848 by 848 pixels:
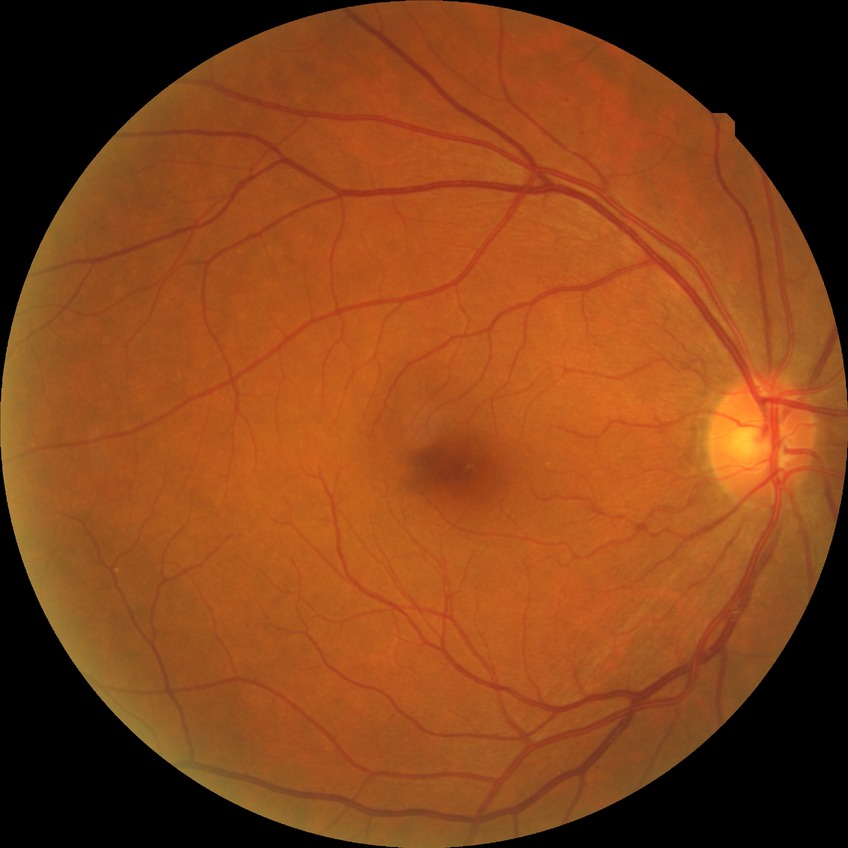 Findings:
– modified Davis classification: simple diabetic retinopathy
– DR class: non-proliferative diabetic retinopathy